Camera: Topcon TRC; 35° field of view before cropping; fundus photograph cropped around the optic nerve head:
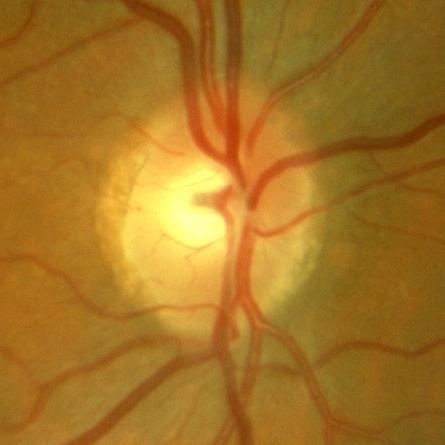

Optic disc appearance consistent with no signs of glaucoma.